CFP — 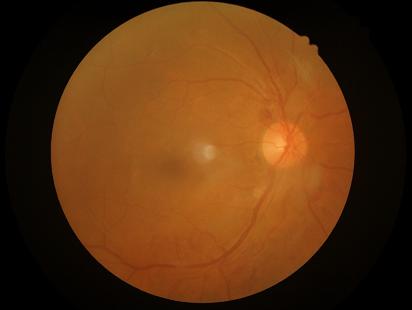
Contrast = good
Sharpness = reduced
Illumination = adequate
Overall = poor